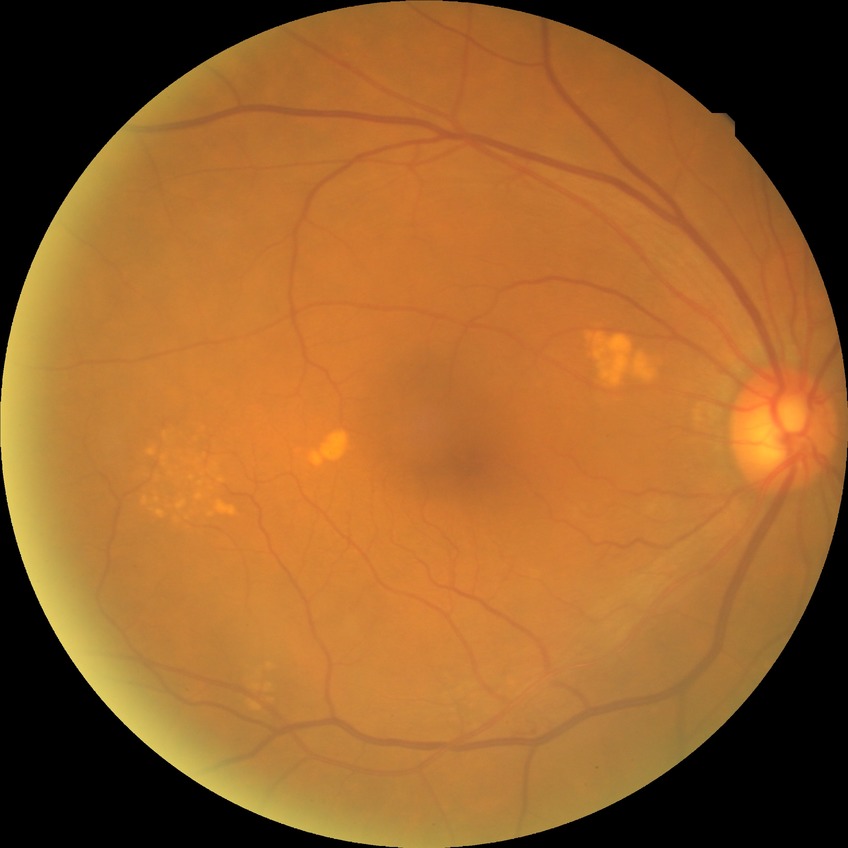 Davis grading is no diabetic retinopathy.